Fundus photo.
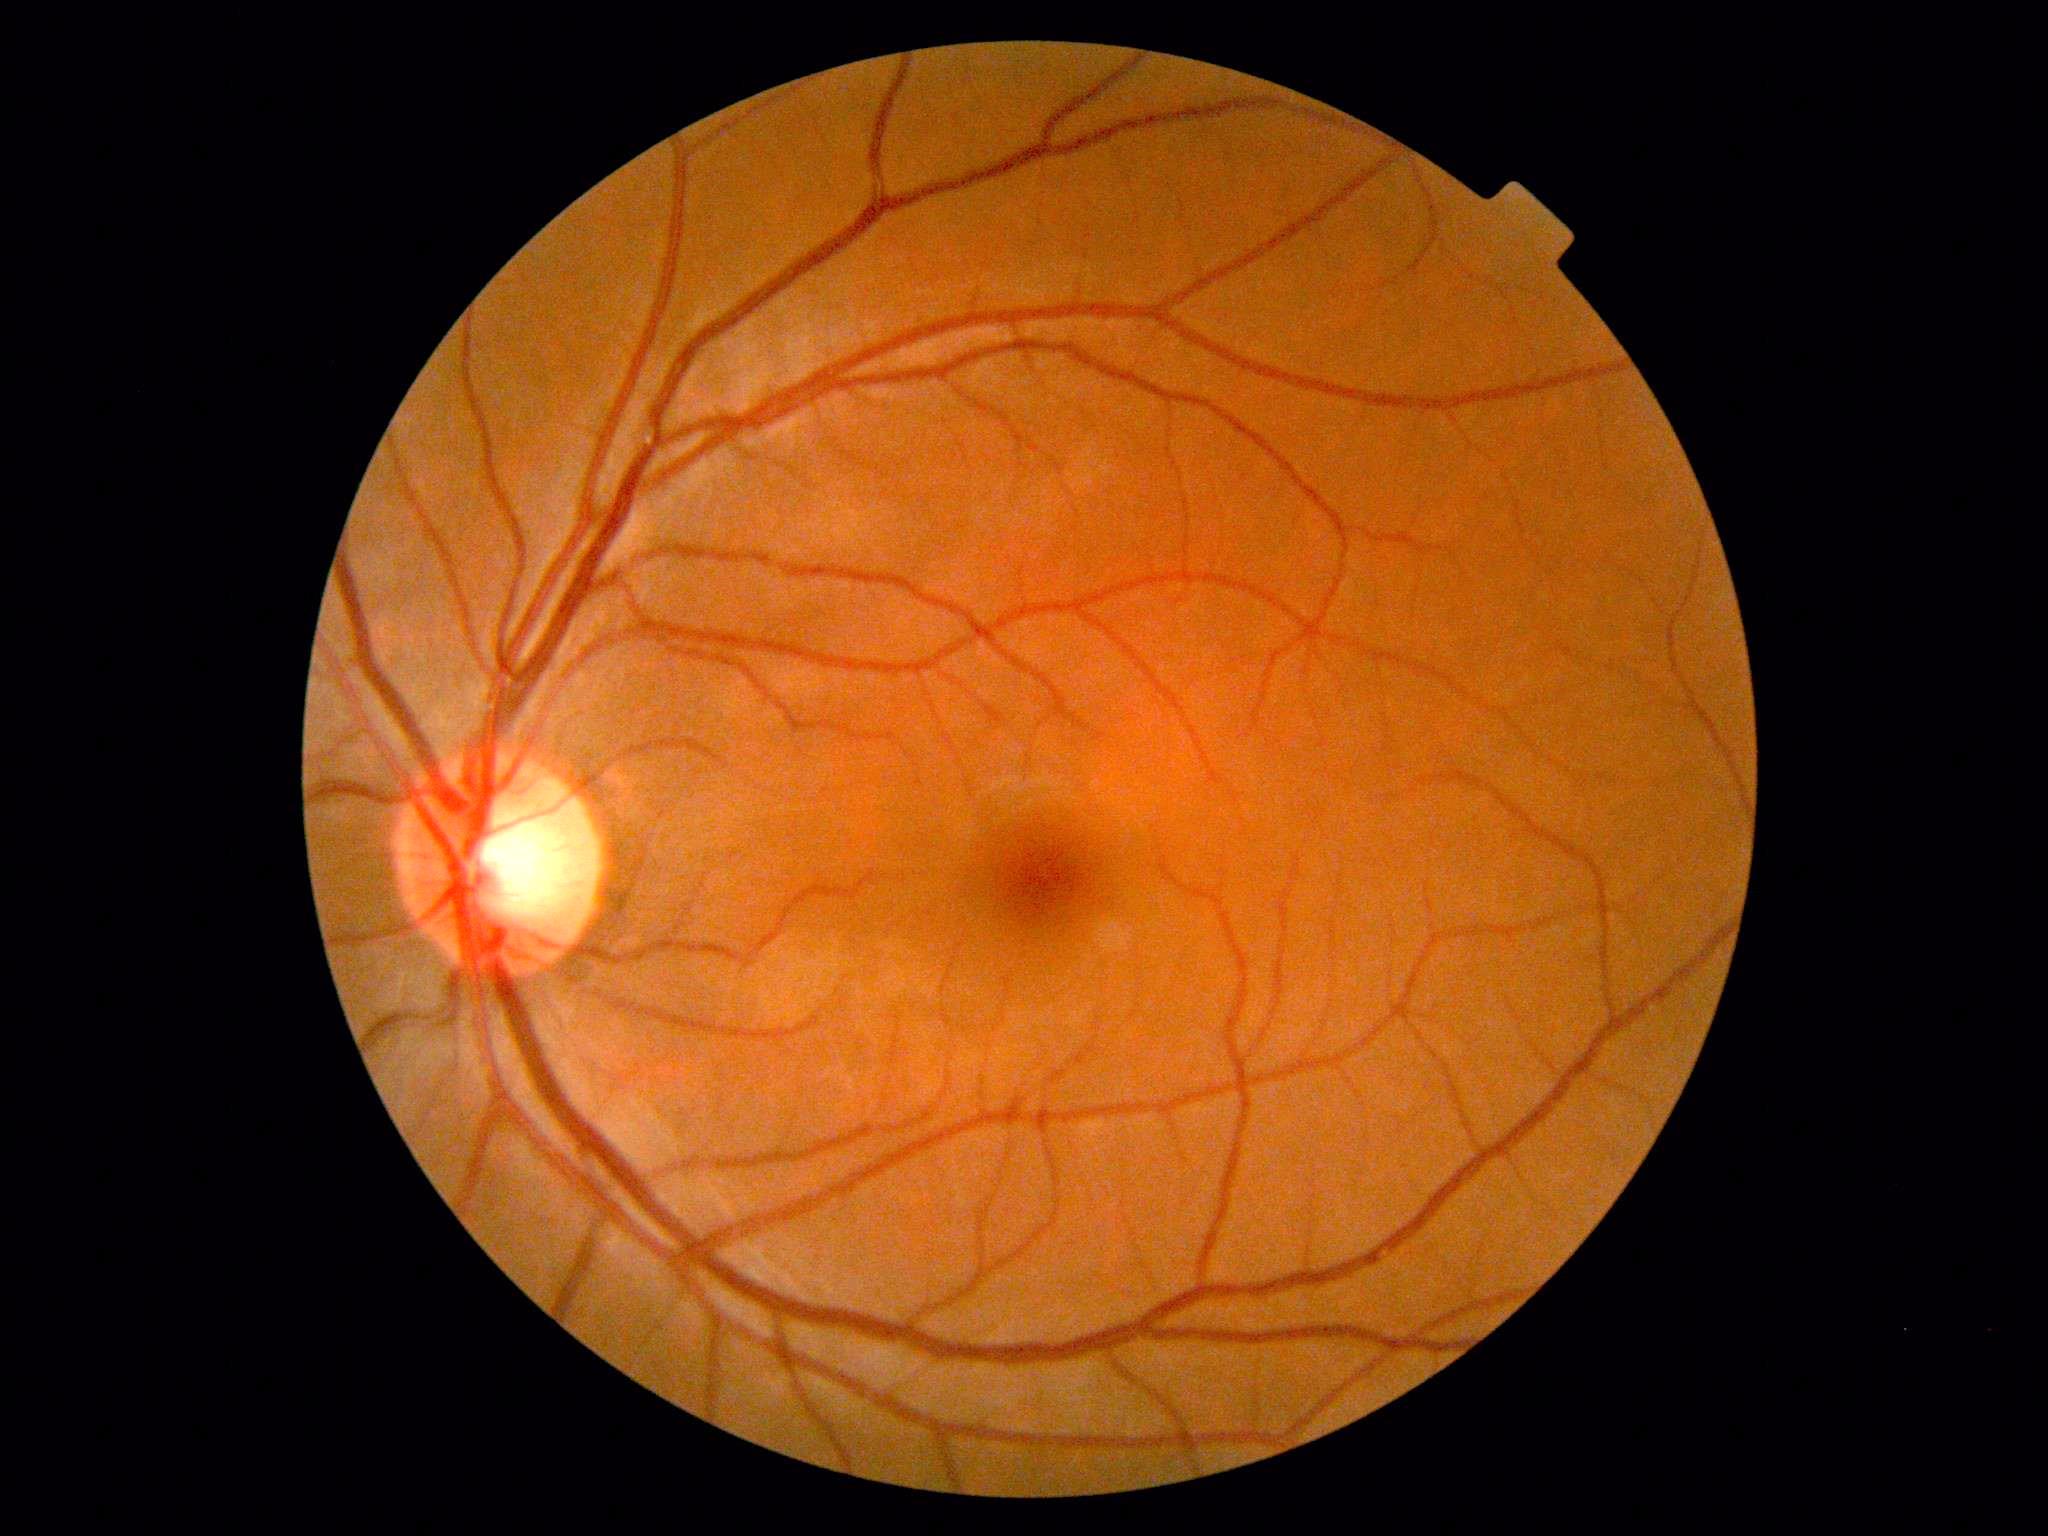 DR stage is 0. No apparent diabetic retinopathy.